Portable fundus photograph; 2212x1659: 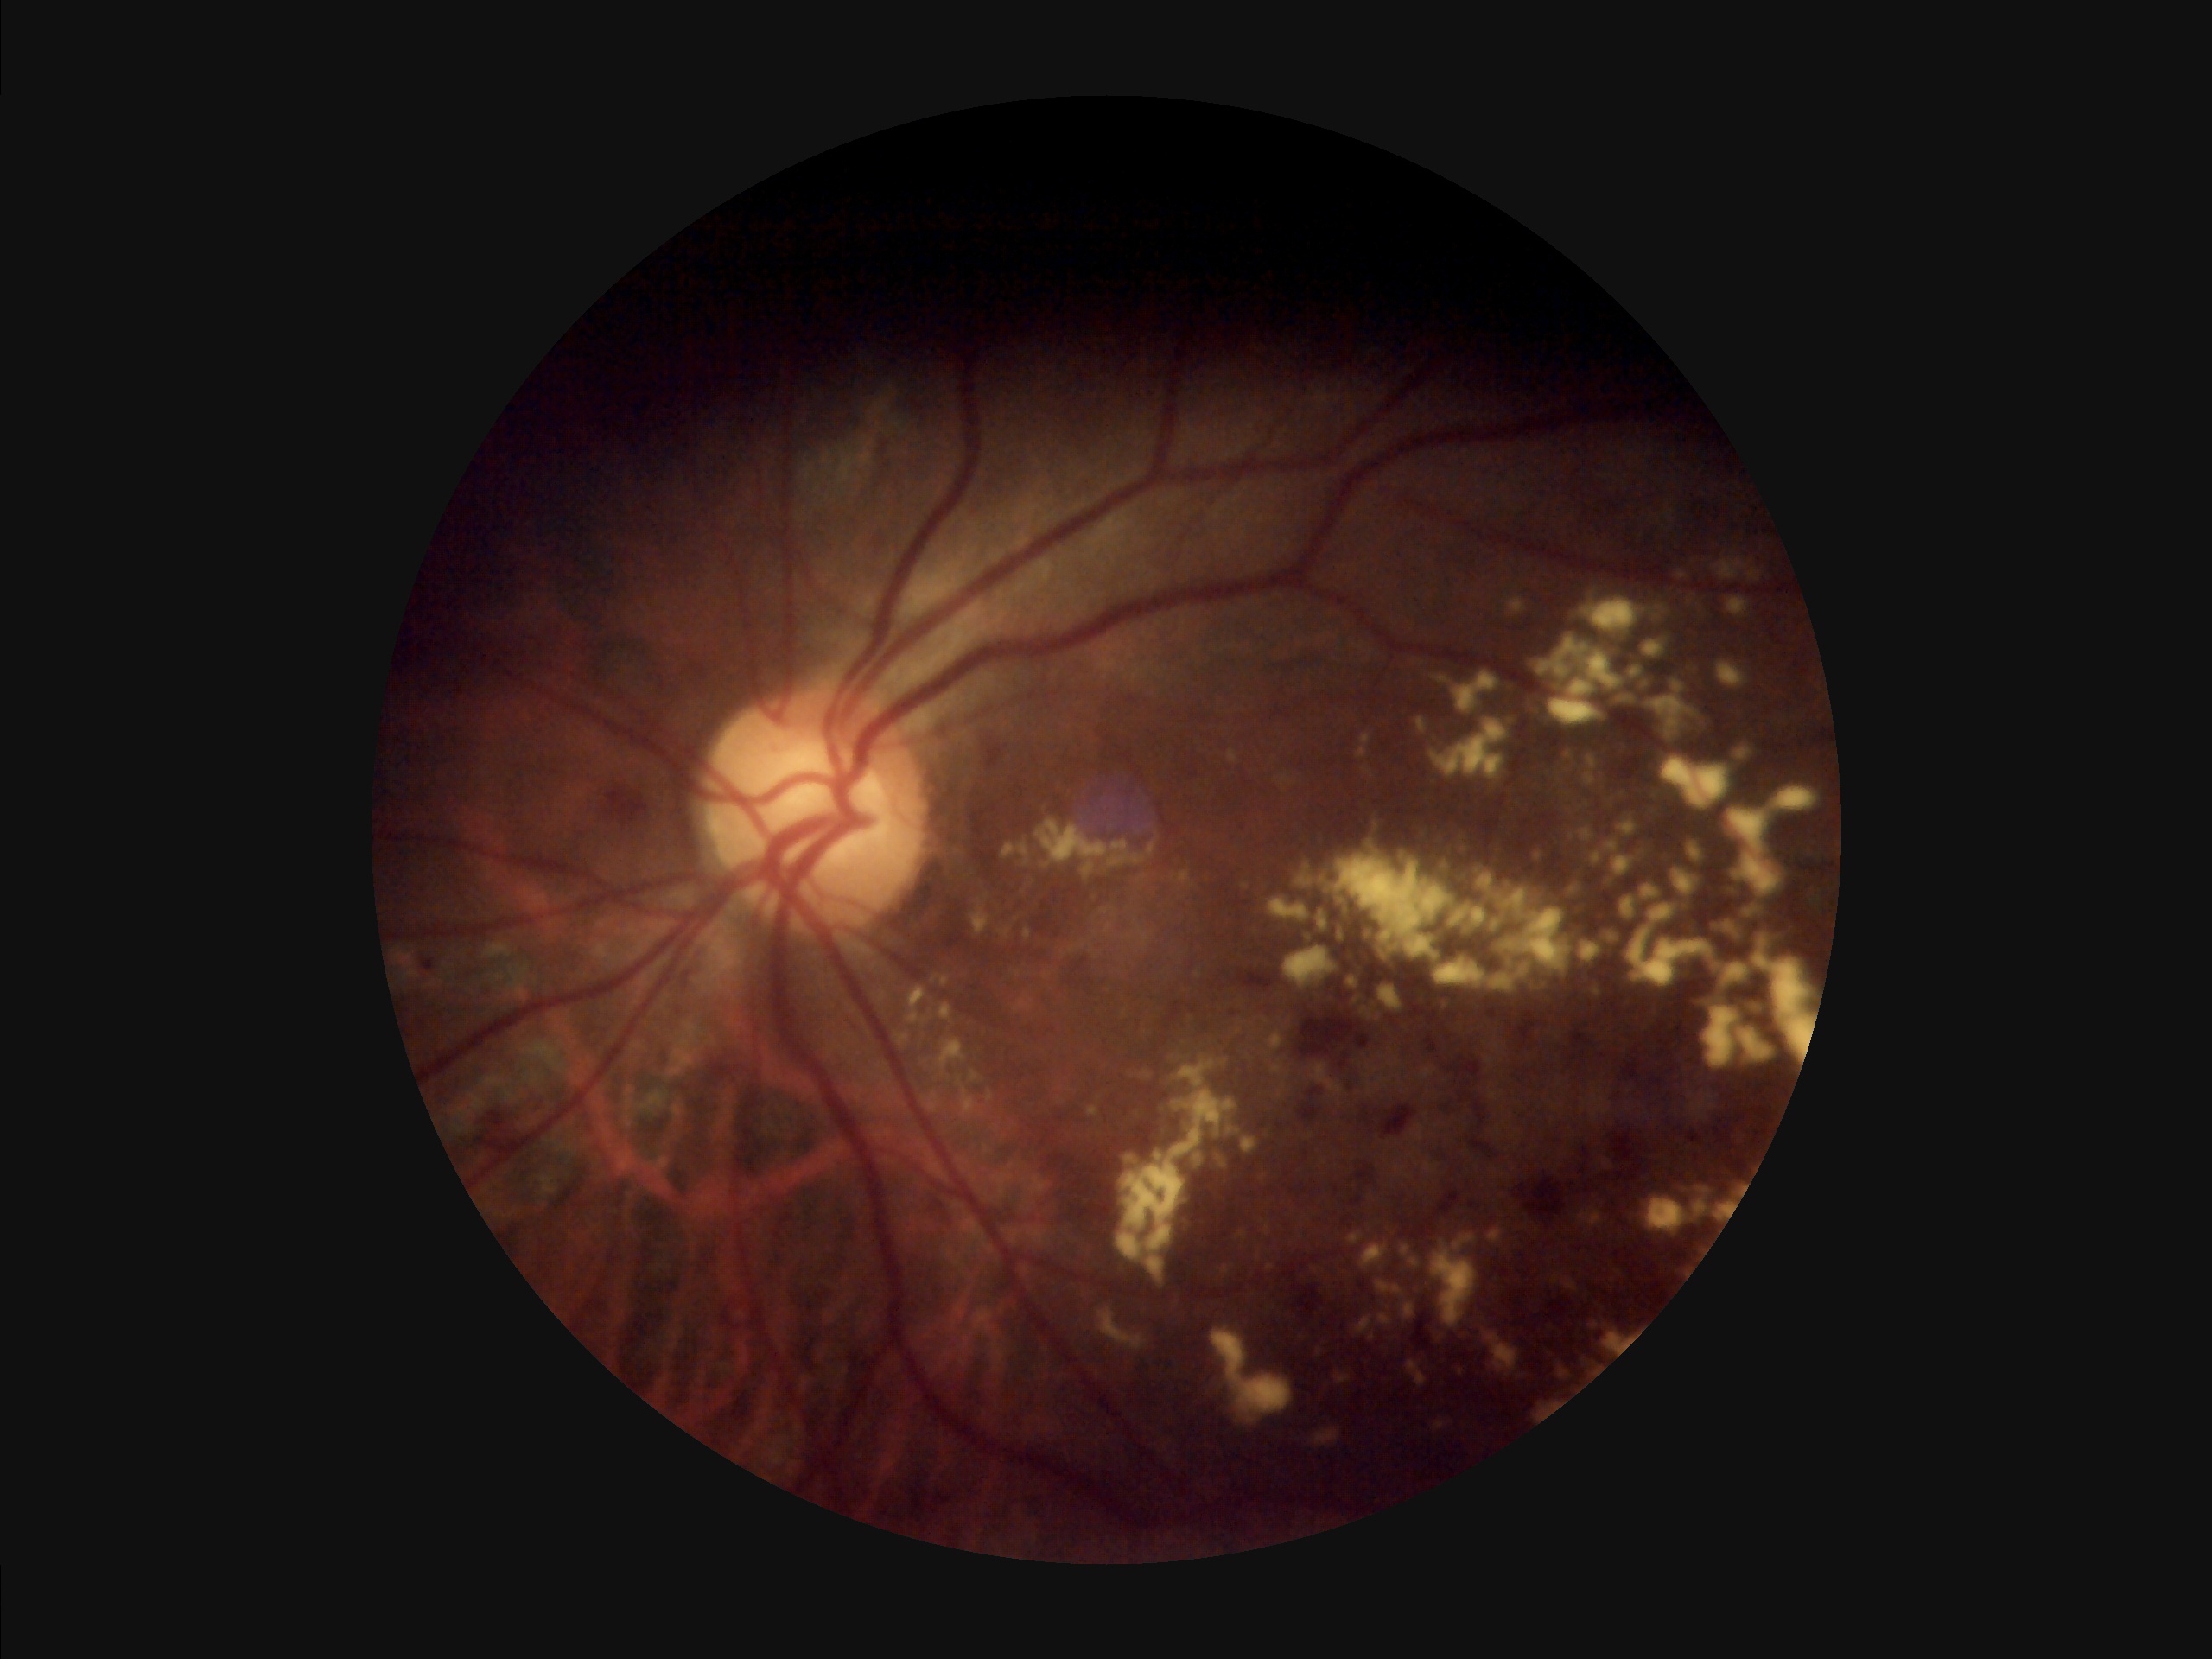

Clarity: clear with no noticeable blur
Illumination/color: over- or under-exposed
Overall quality: inadequate for clinical interpretation
Contrast: poor dynamic range